Centered on the macula, pupil-dilated:
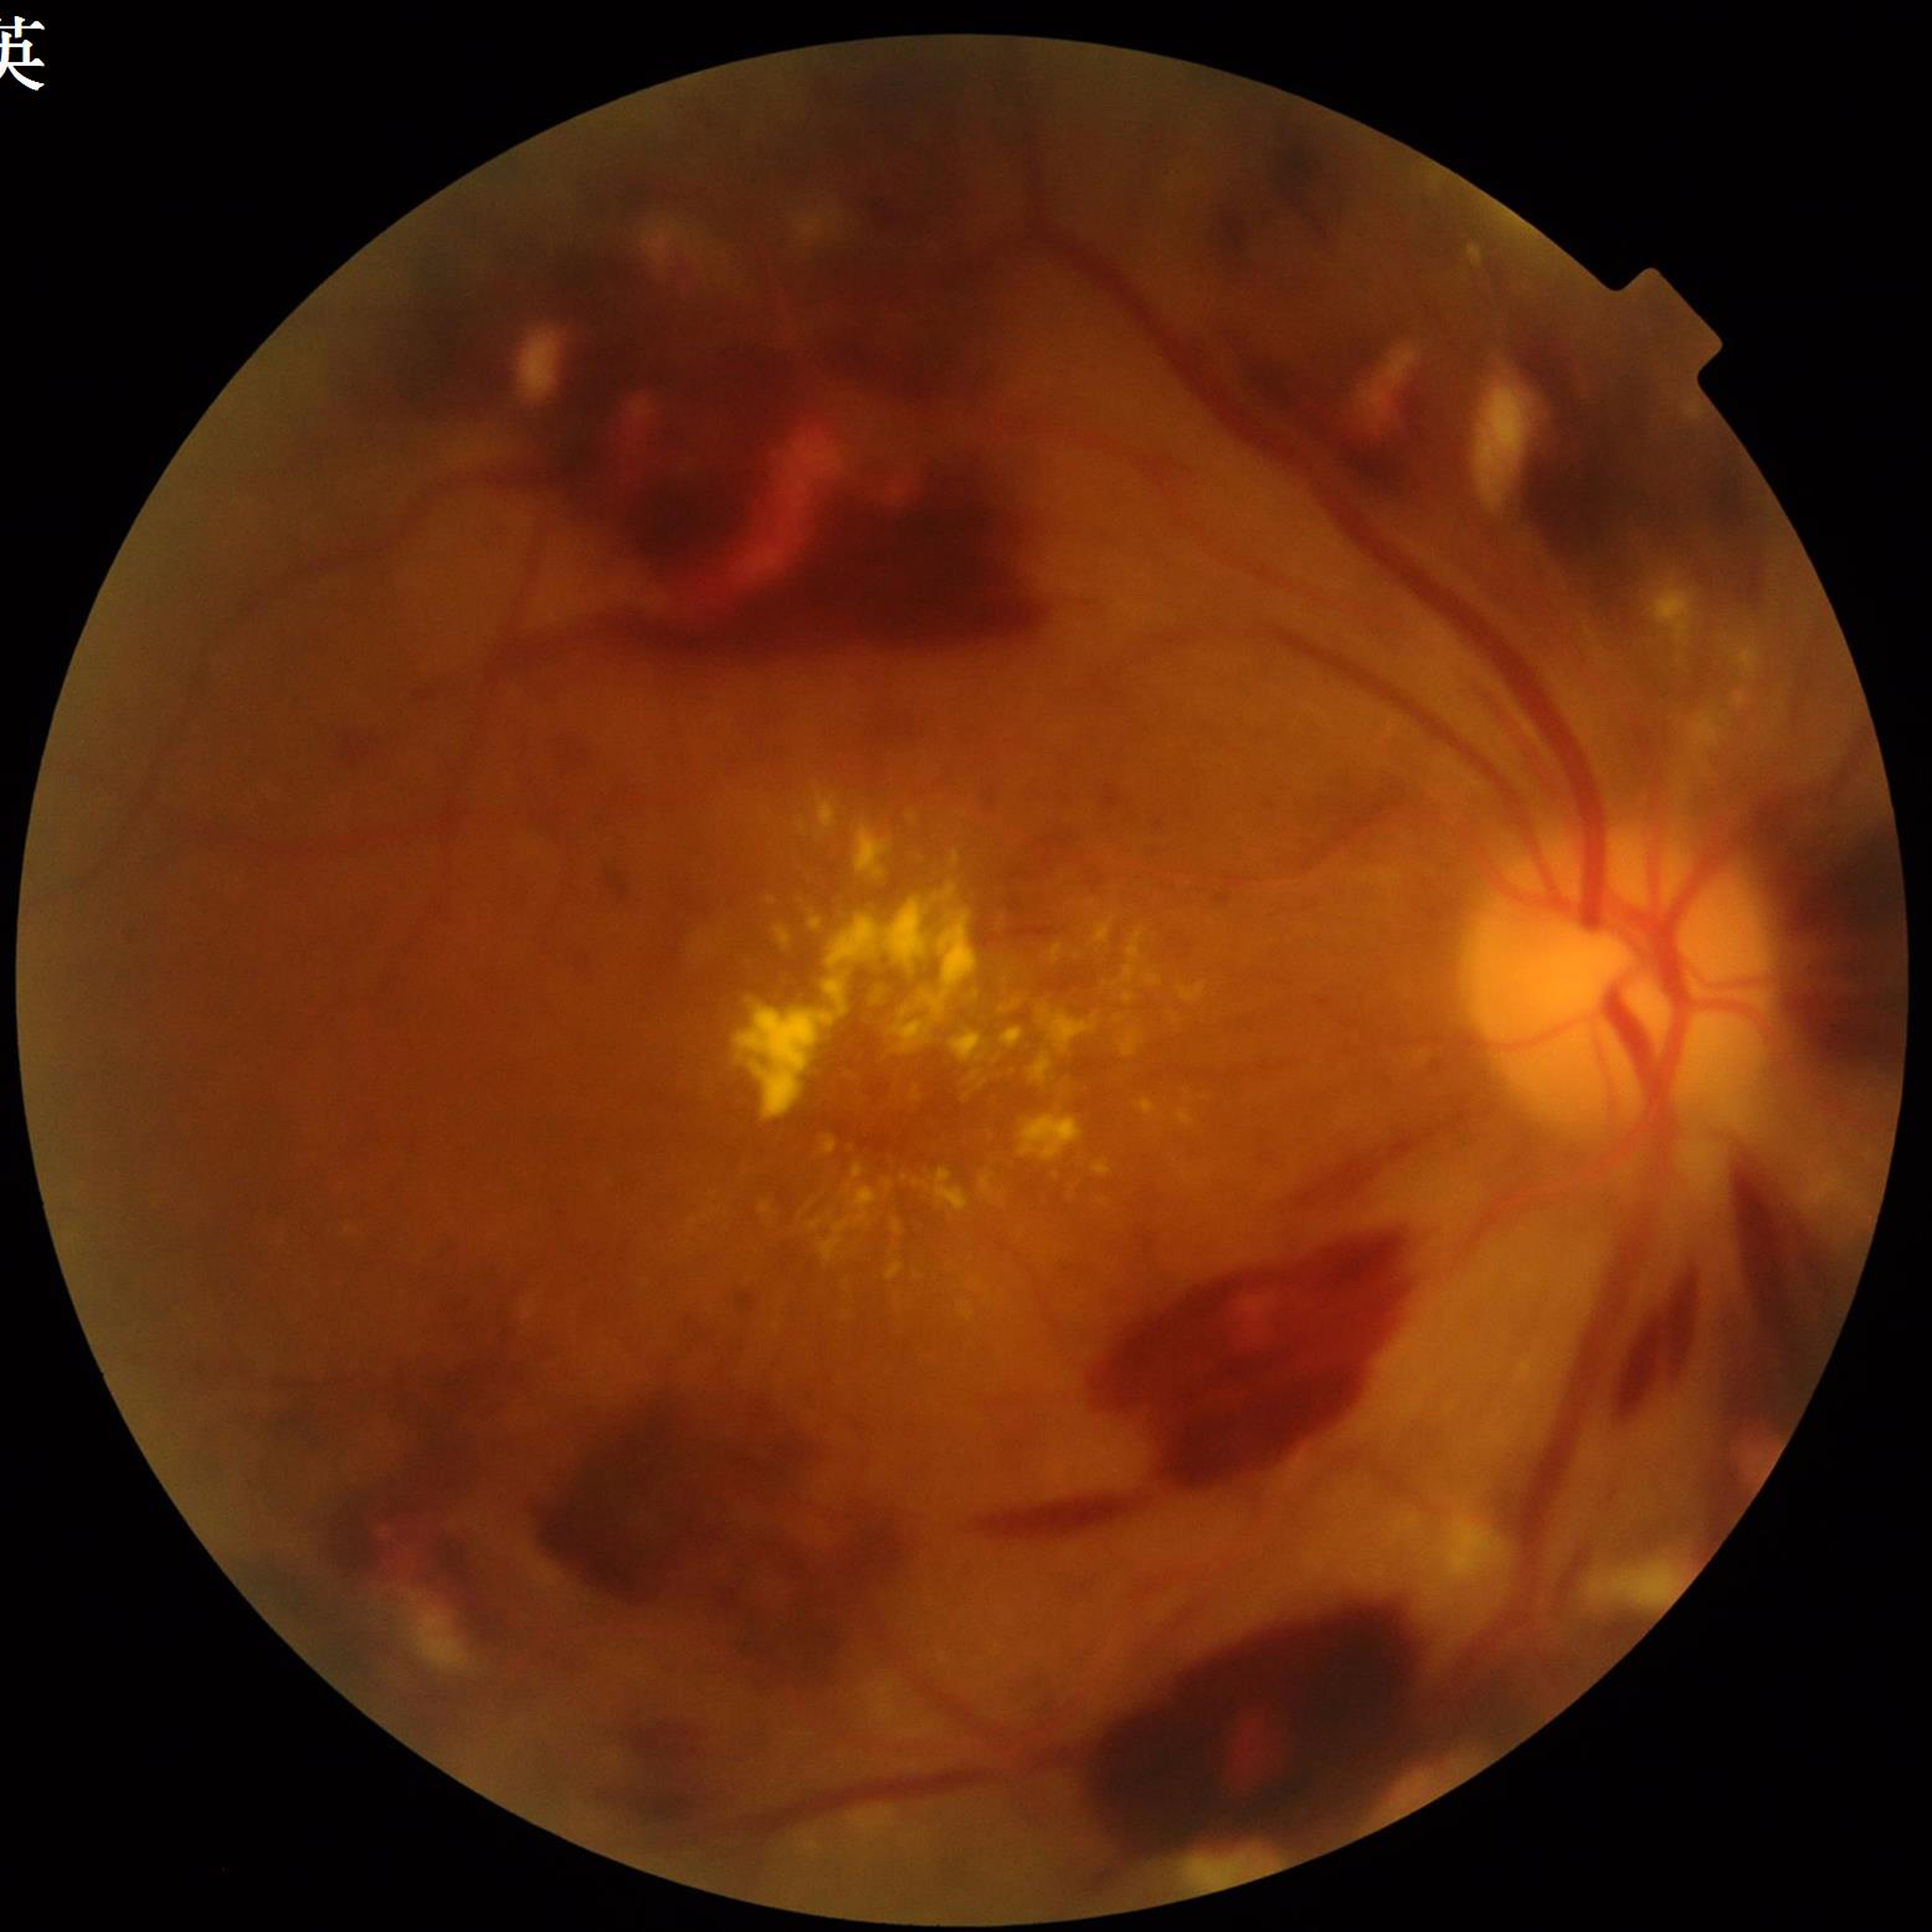
Disease class: diabetic retinopathy (DR)
Photo quality: suboptimal — blur